1240 by 1240 pixels. Wide-field fundus image from infant ROP screening: 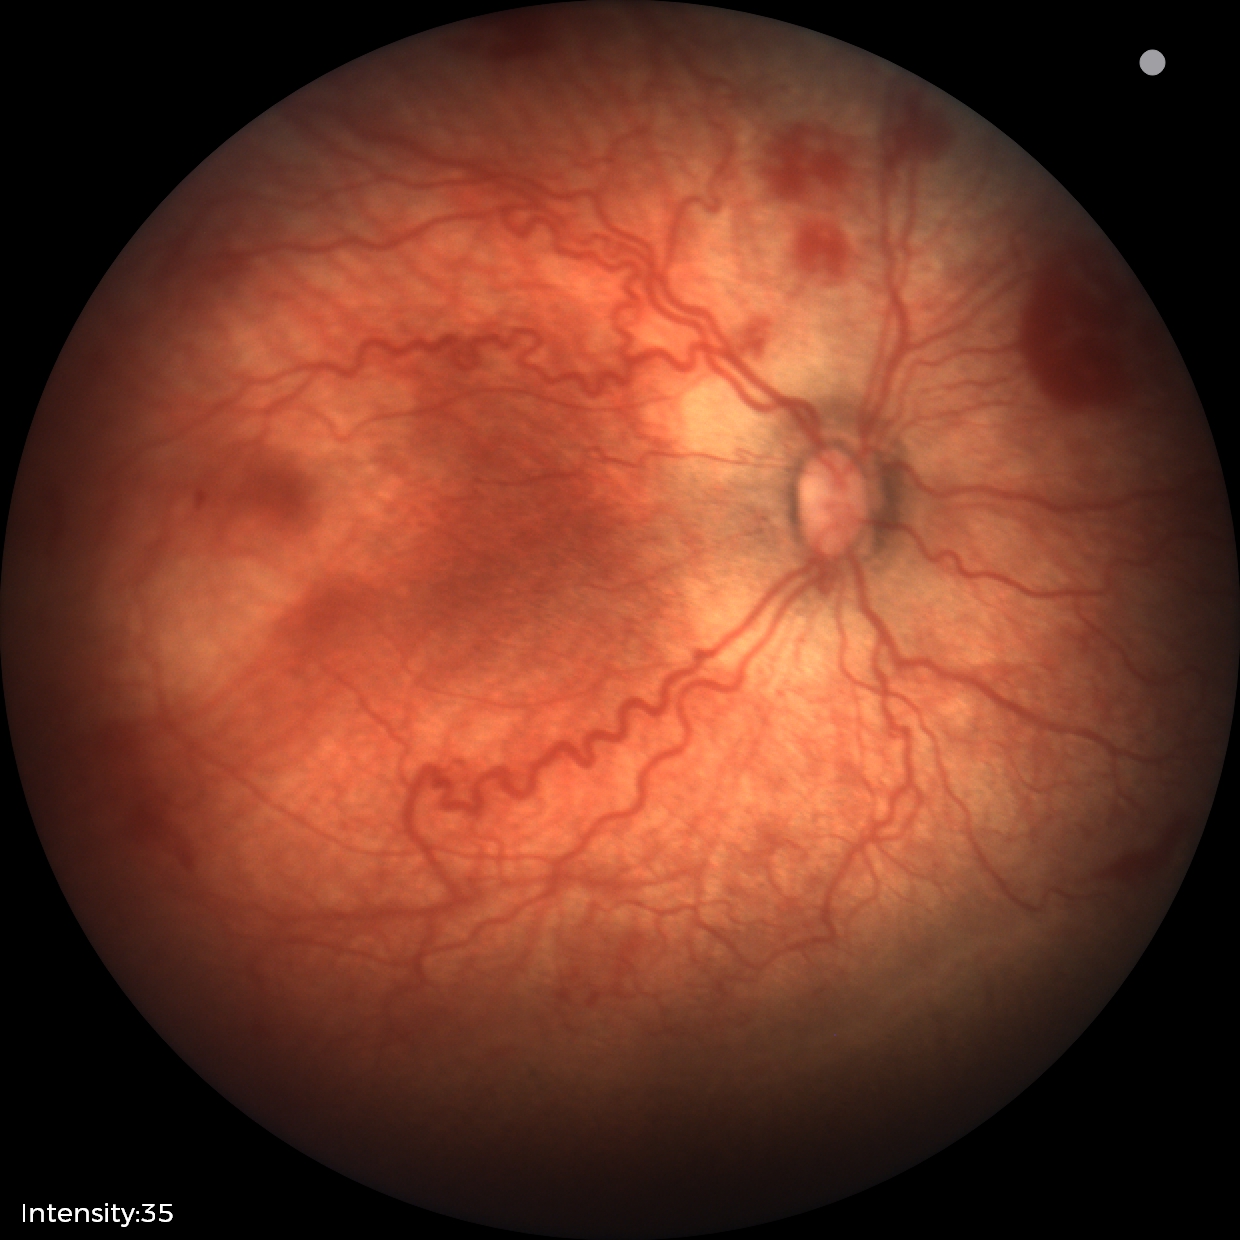
Plus disease was diagnosed. Examination diagnosed as retinopathy of prematurity (ROP) stage 2 — ridge with height and width at the demarcation line.